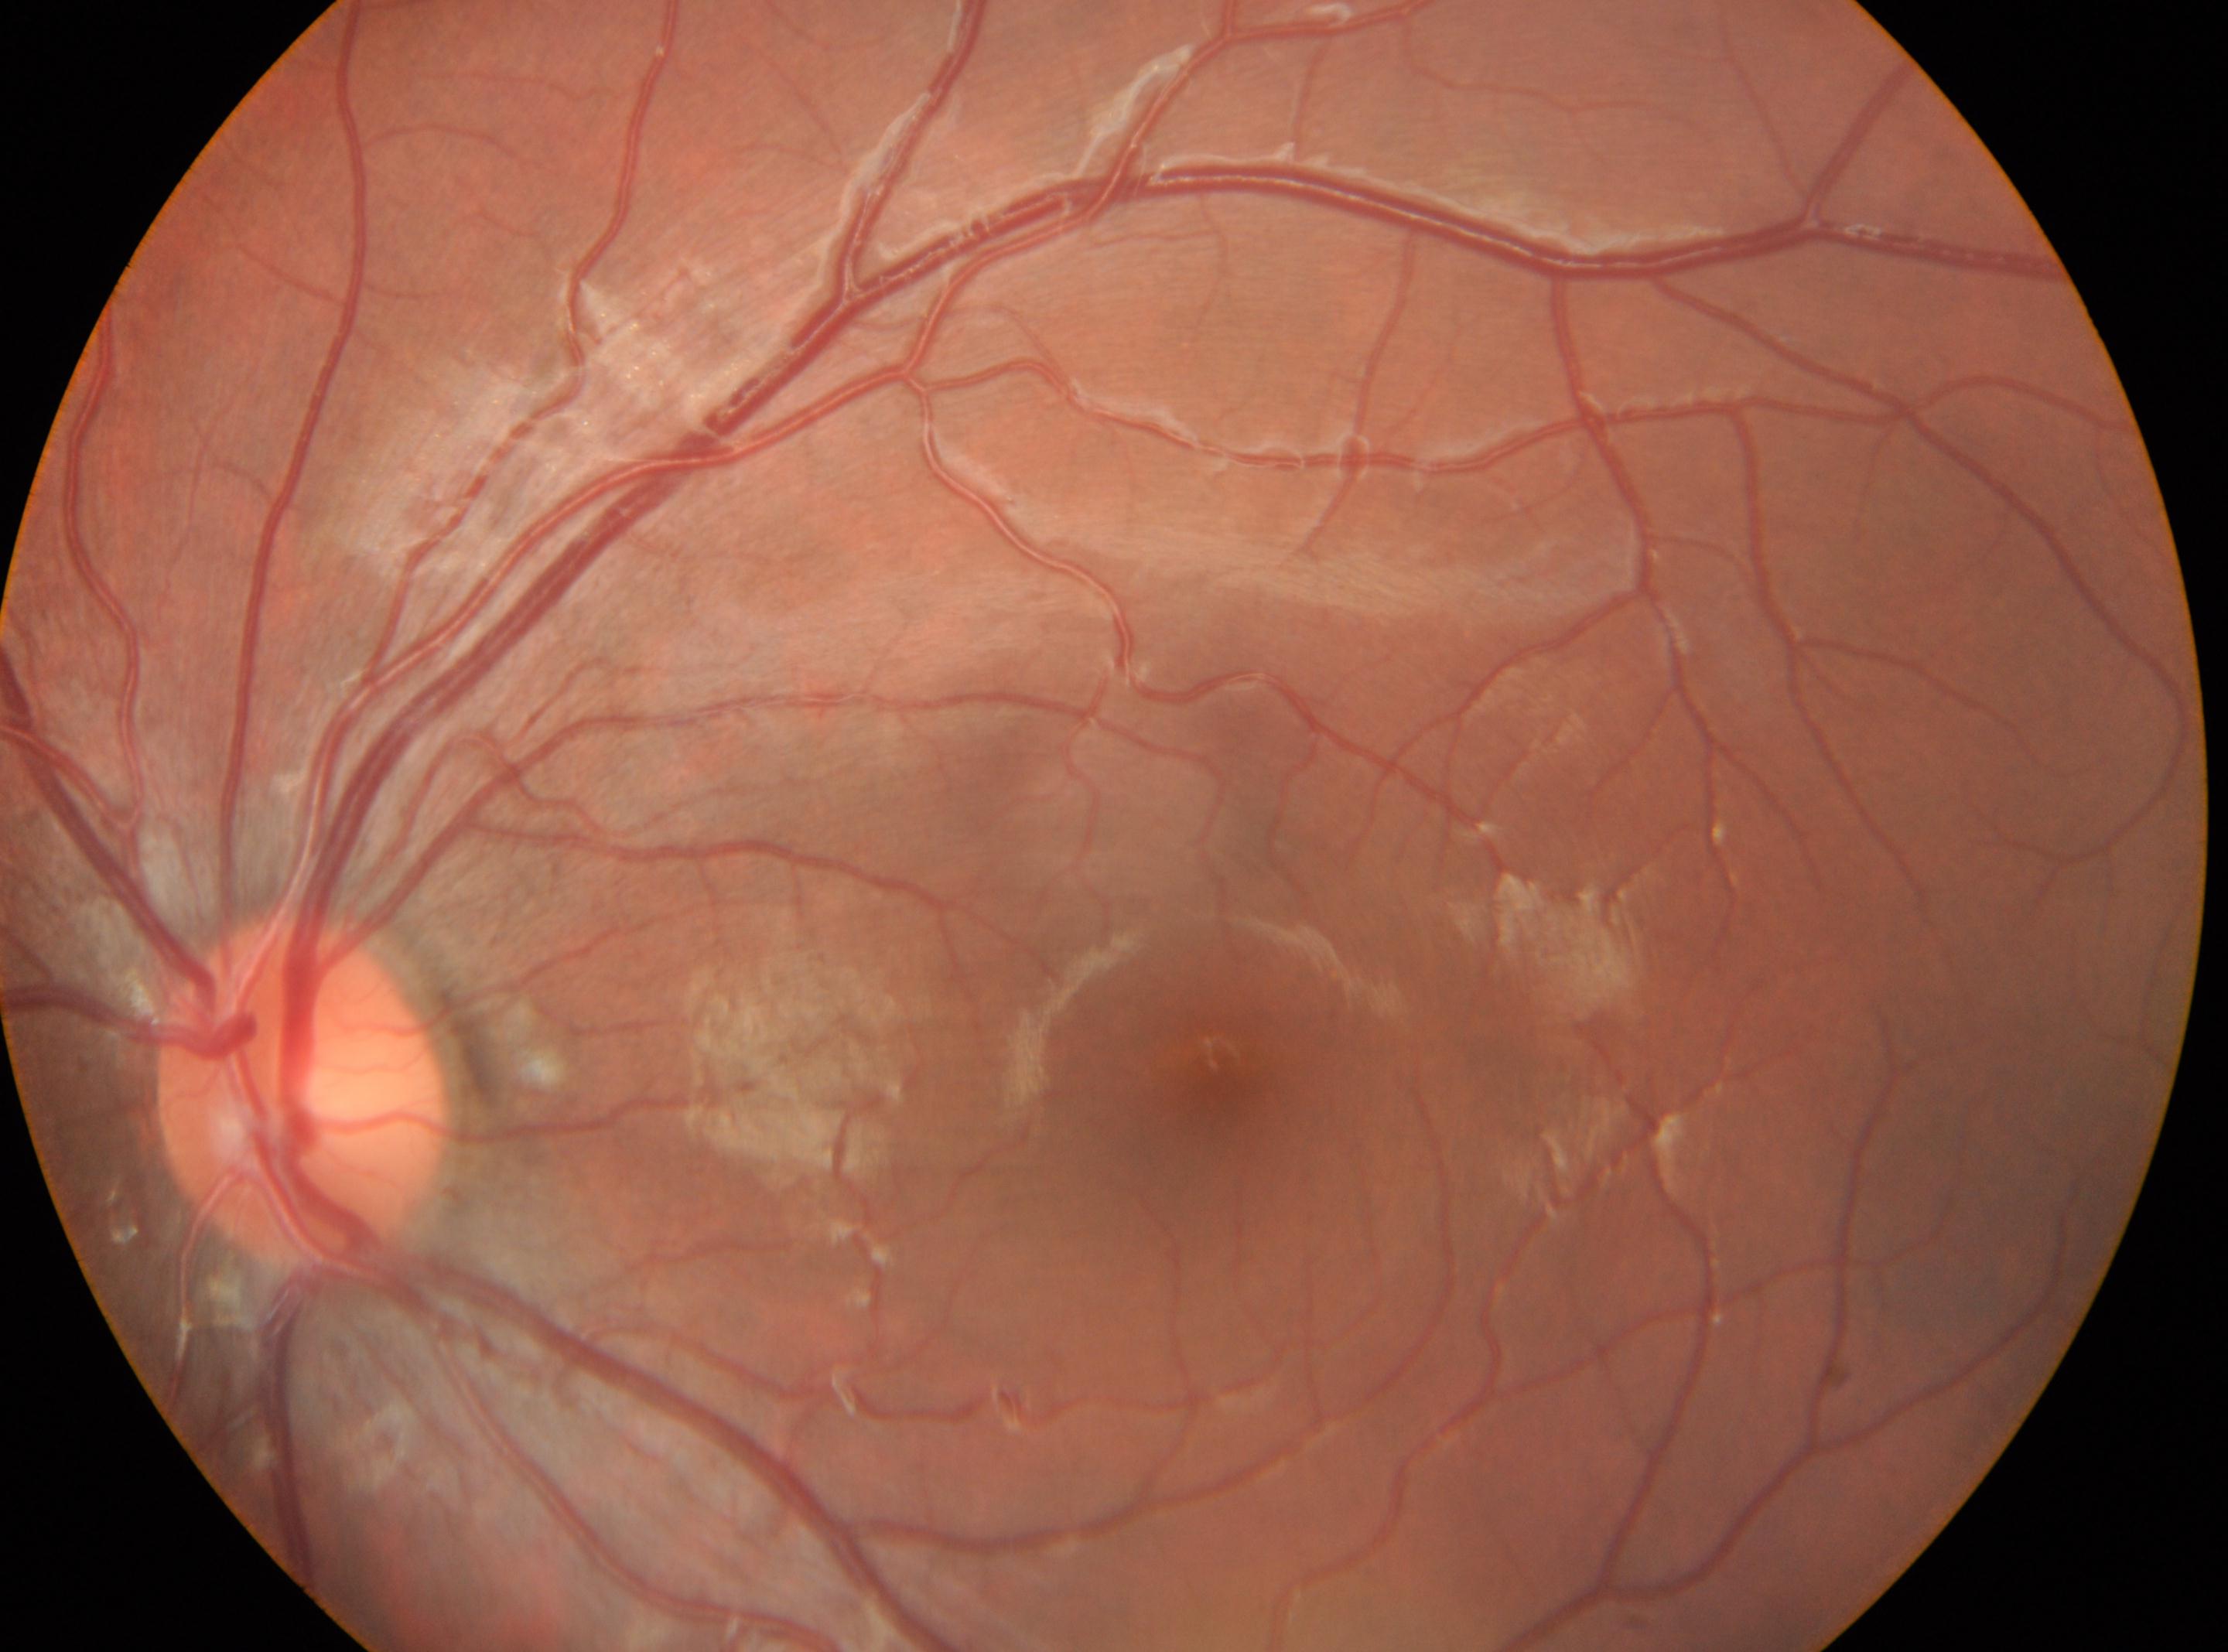 This is the left eye.
Optic disc: (302,1091).
Macula center: (1216,1066).
Diabetic retinopathy severity is 0/4.